2352x1568 · fundus photo: 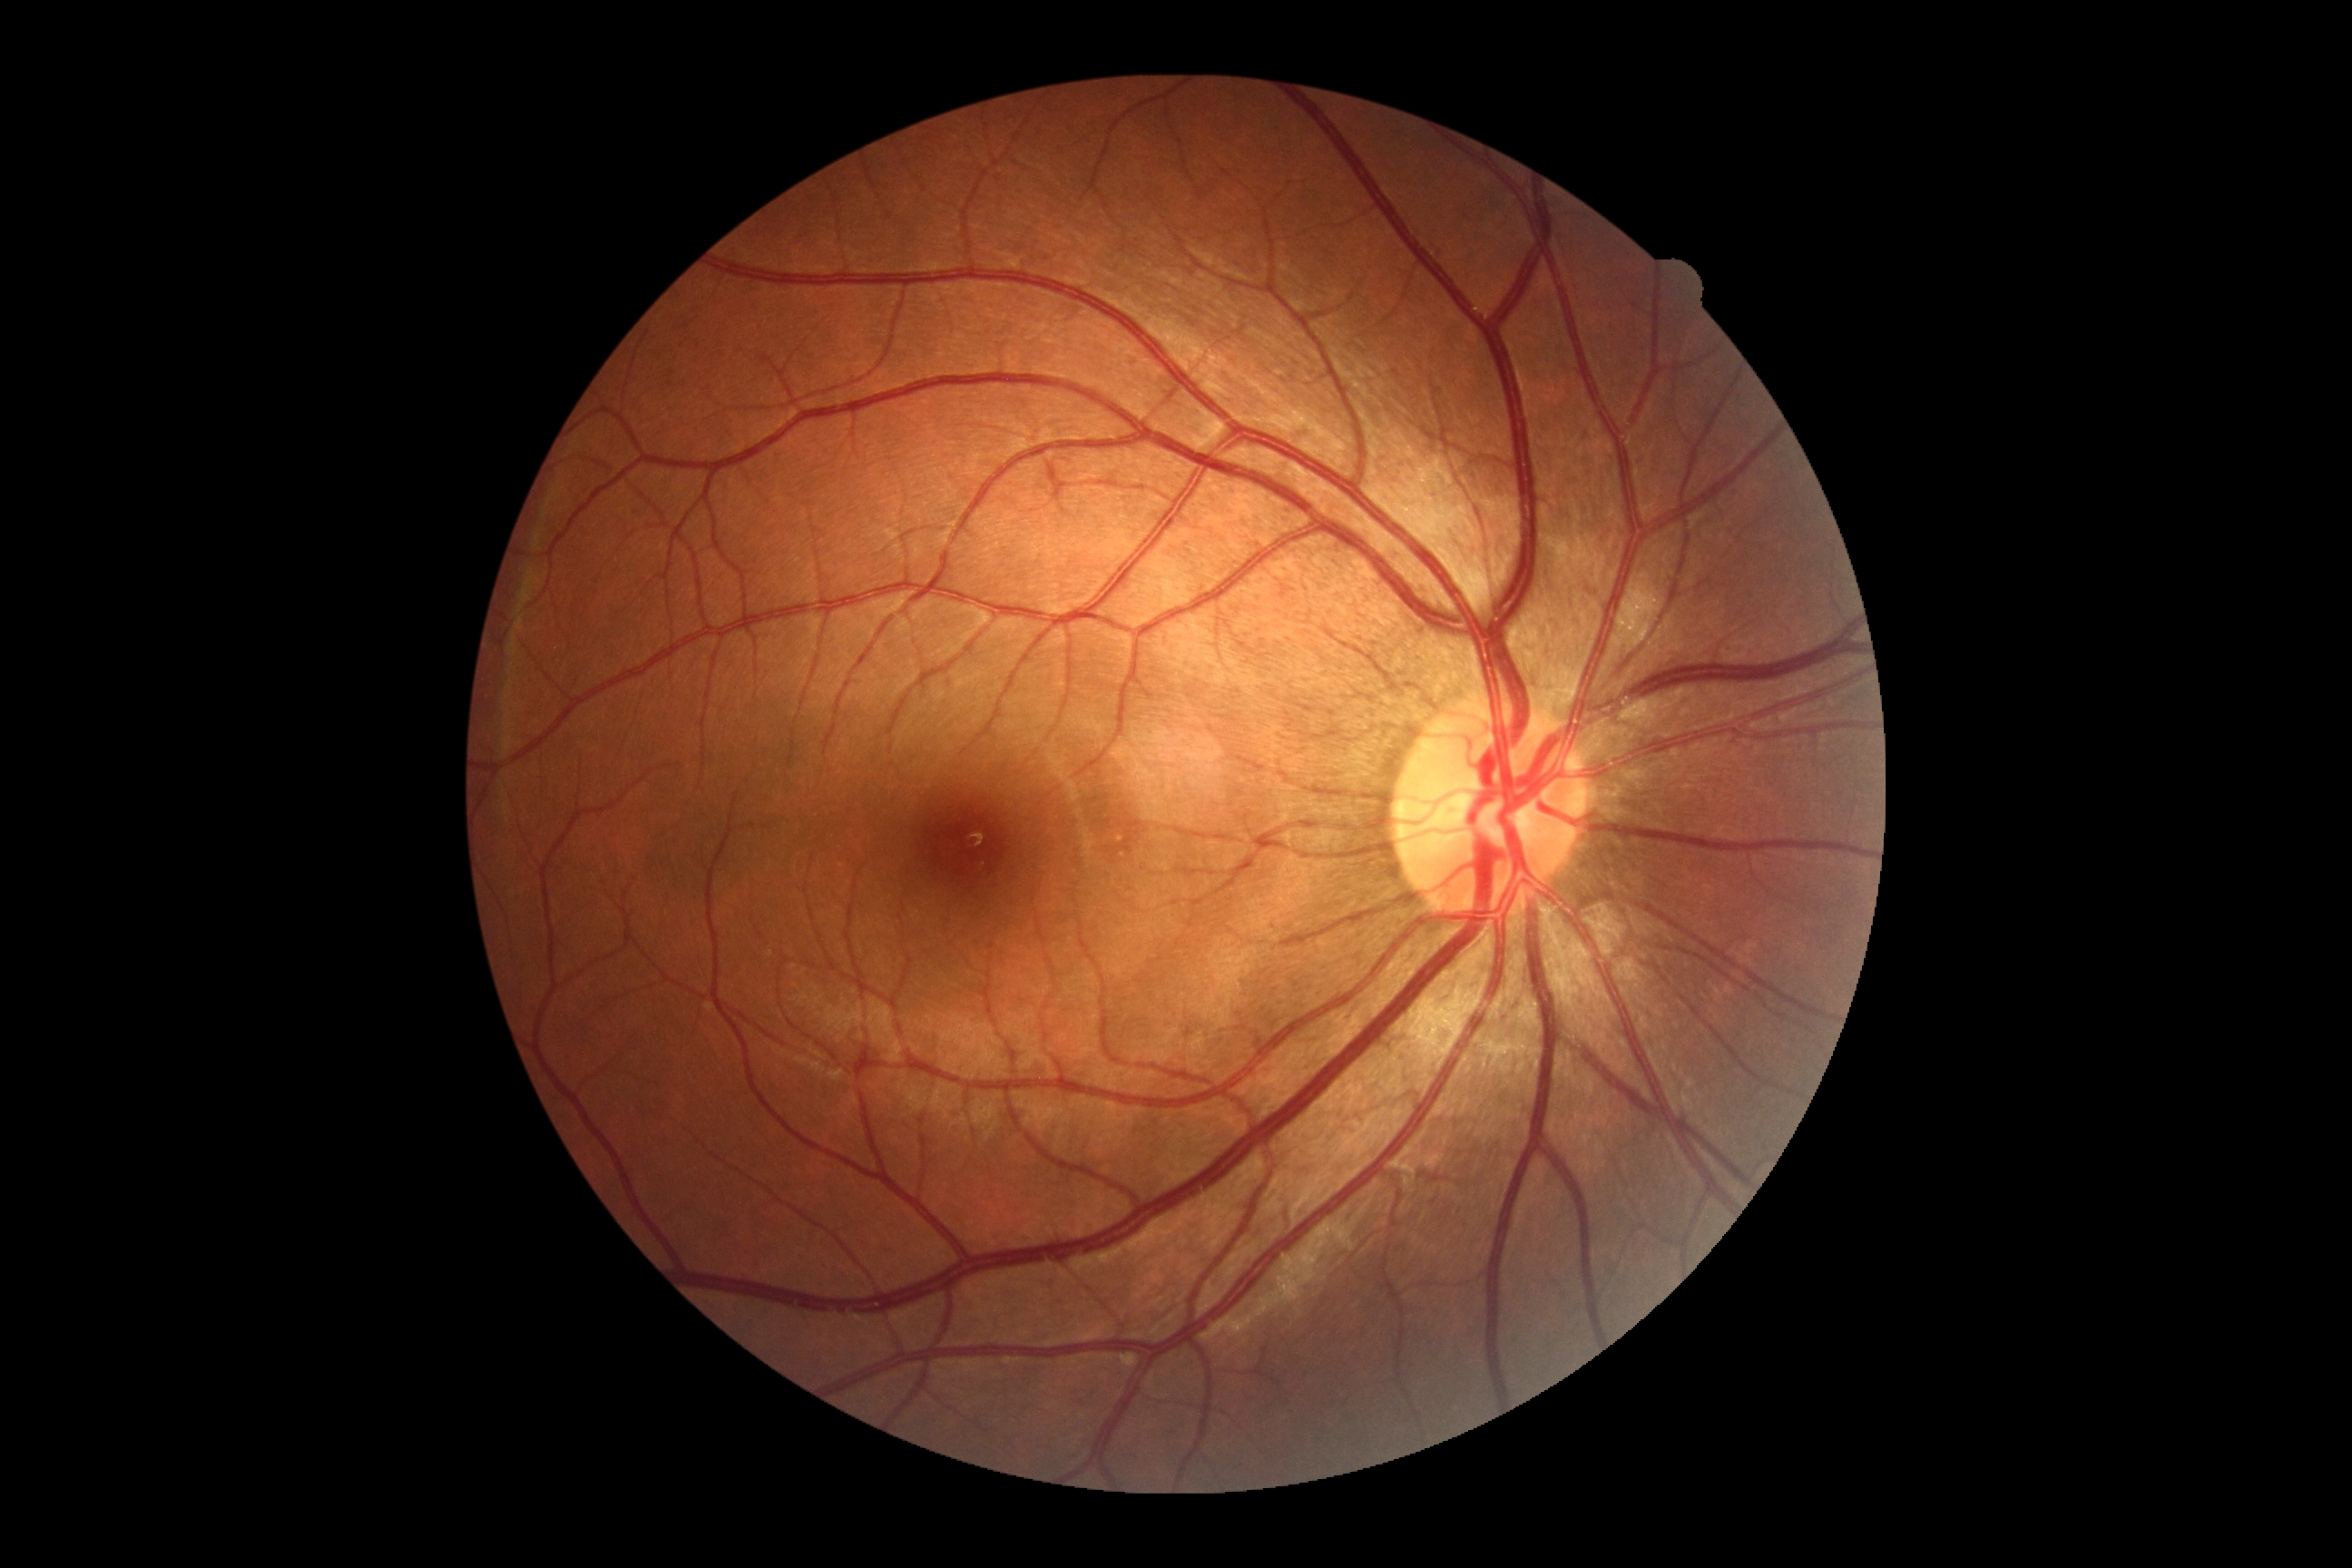
DR grade is 0.